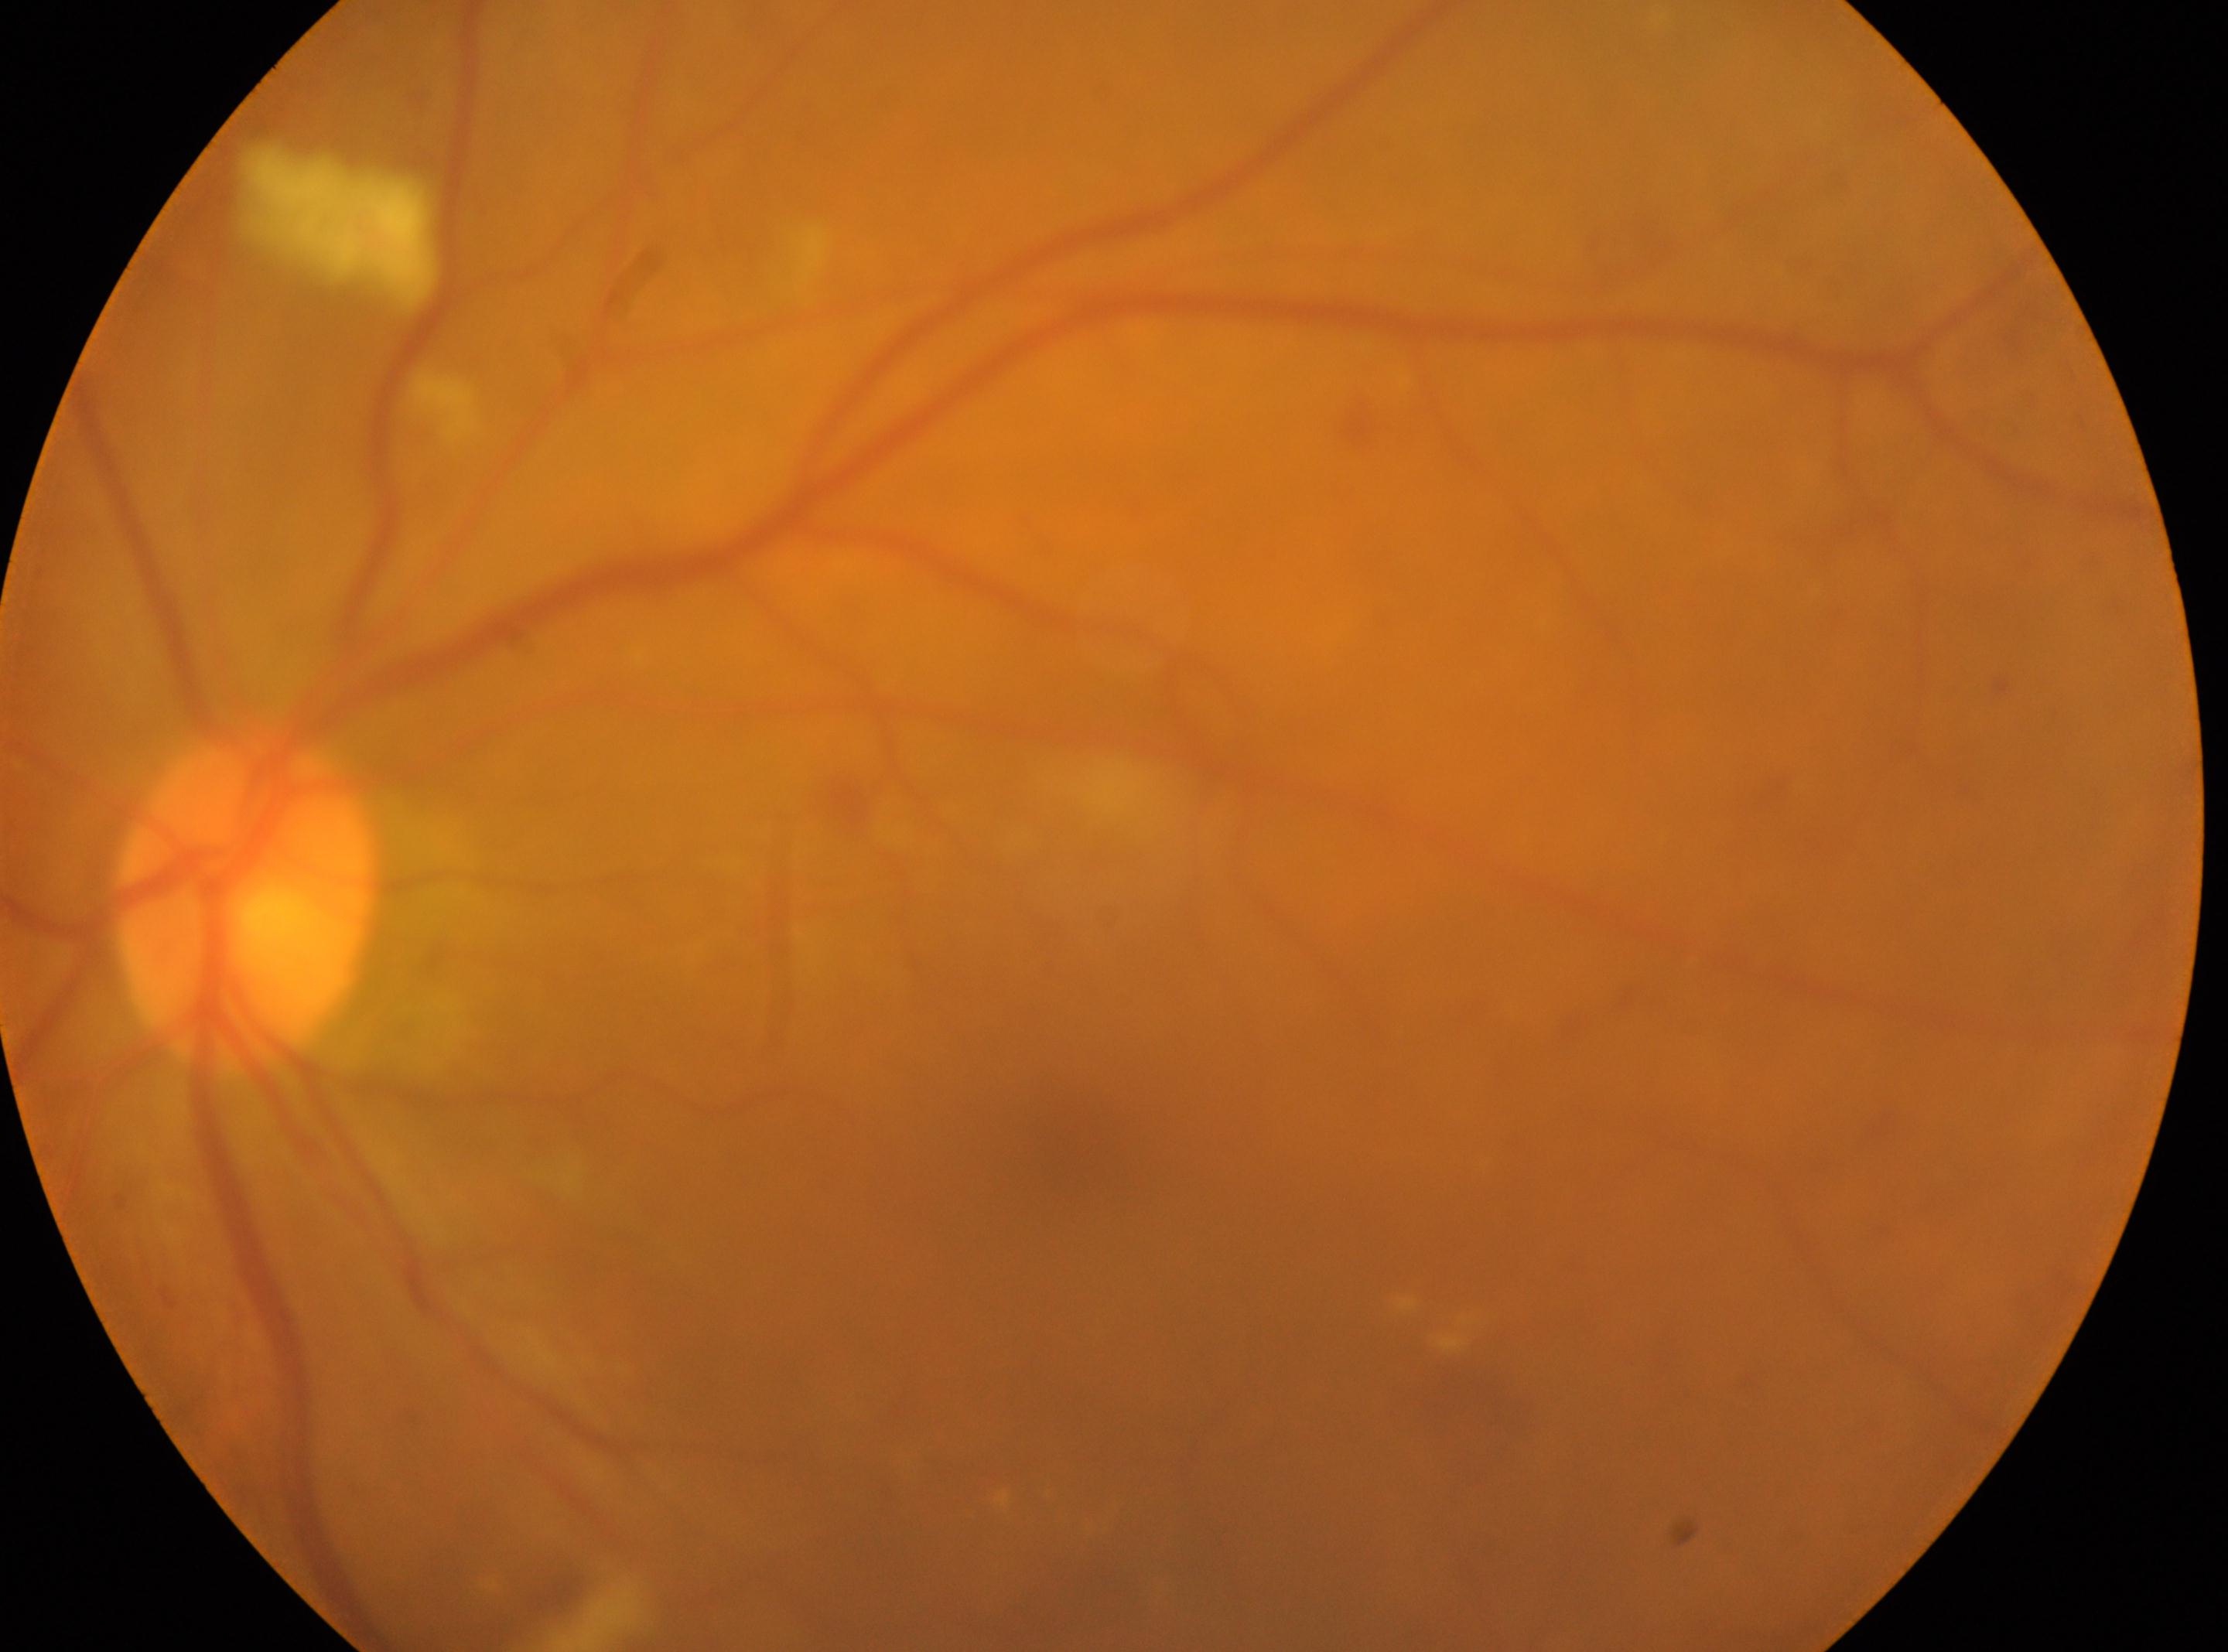
The optic nerve head is at x=243, y=905.
Fovea: x=1068, y=1180.
Diabetic retinopathy is moderate non-proliferative diabetic retinopathy (grade 2) — more than just microaneurysms but less than severe NPDR.
Imaged eye: left eye.